640 x 480 pixels. Pediatric wide-field fundus photograph — 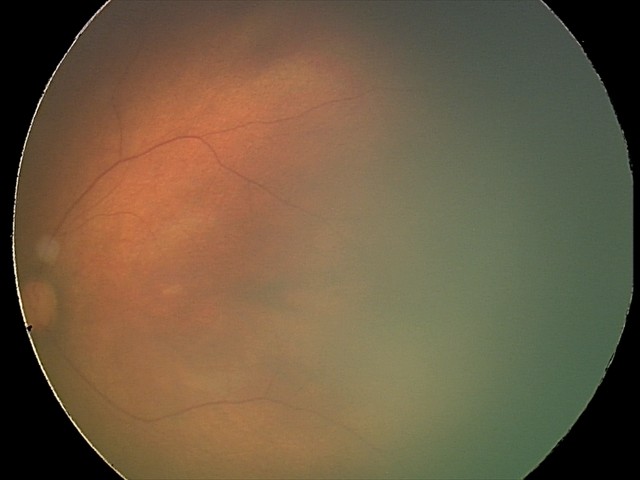 Screening diagnosis: physiological finding.